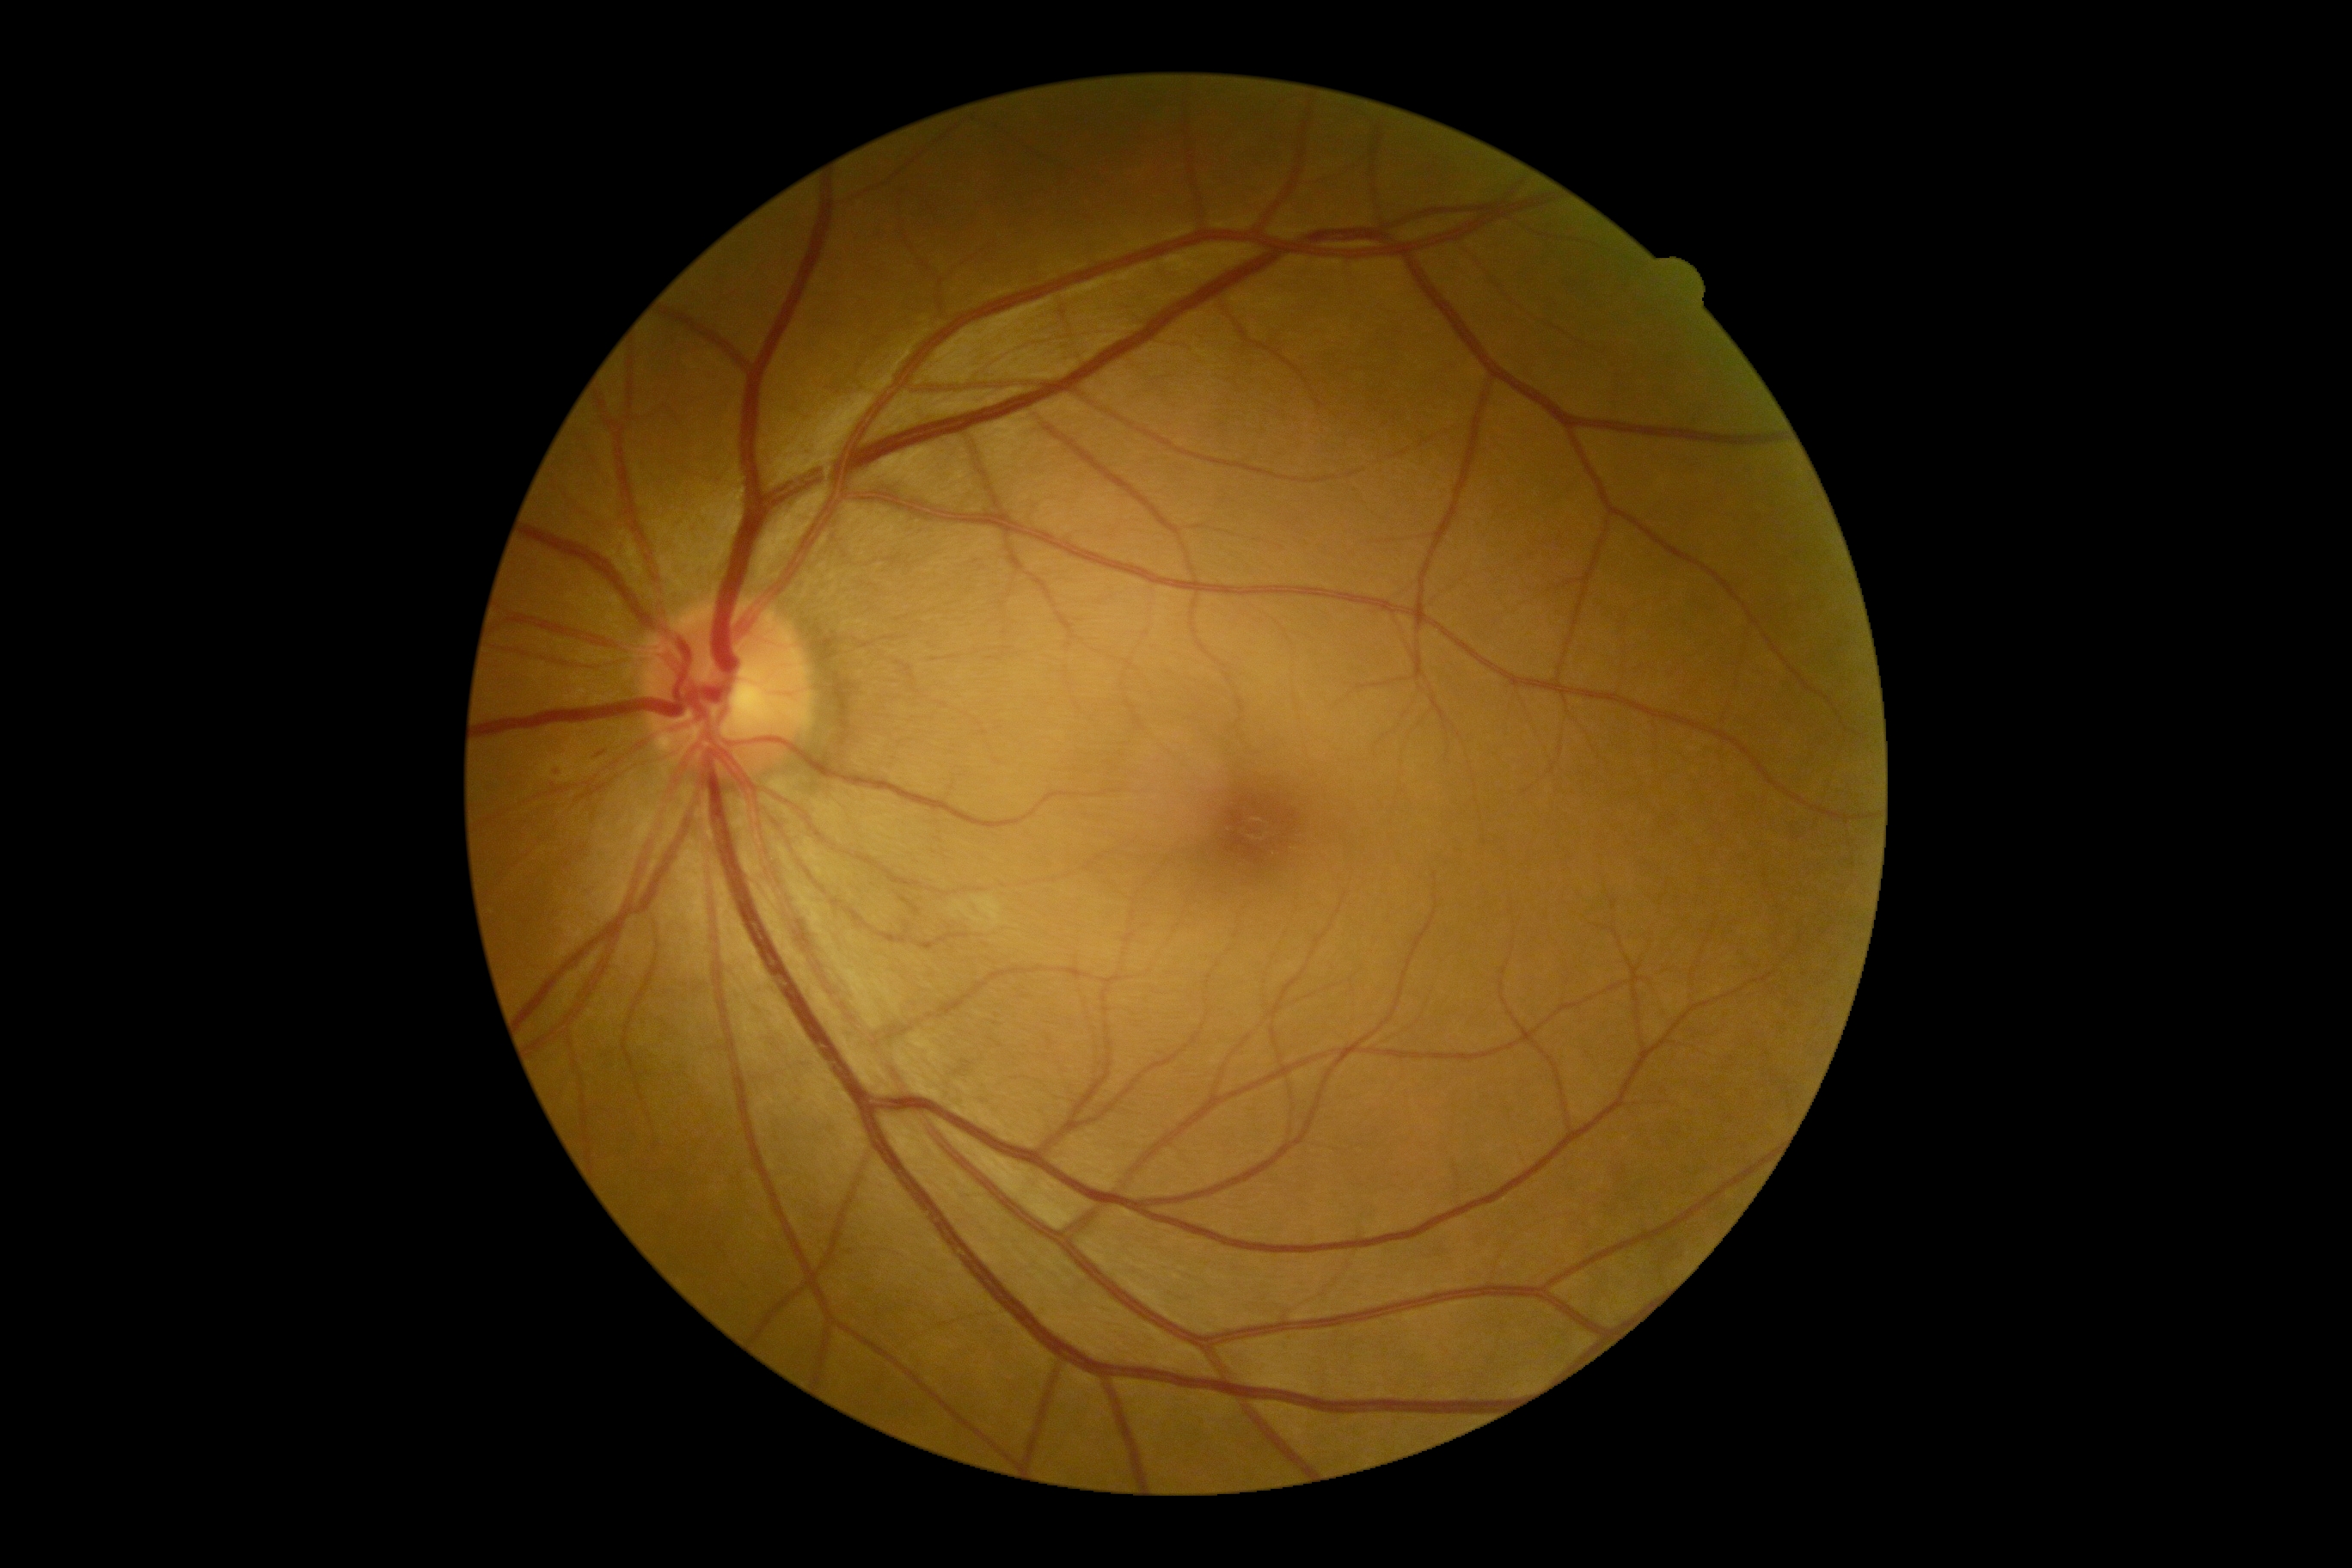   dr_grade: grade 2 (moderate NPDR) — more than just microaneurysms but less than severe NPDR